Infant wide-field fundus photograph.
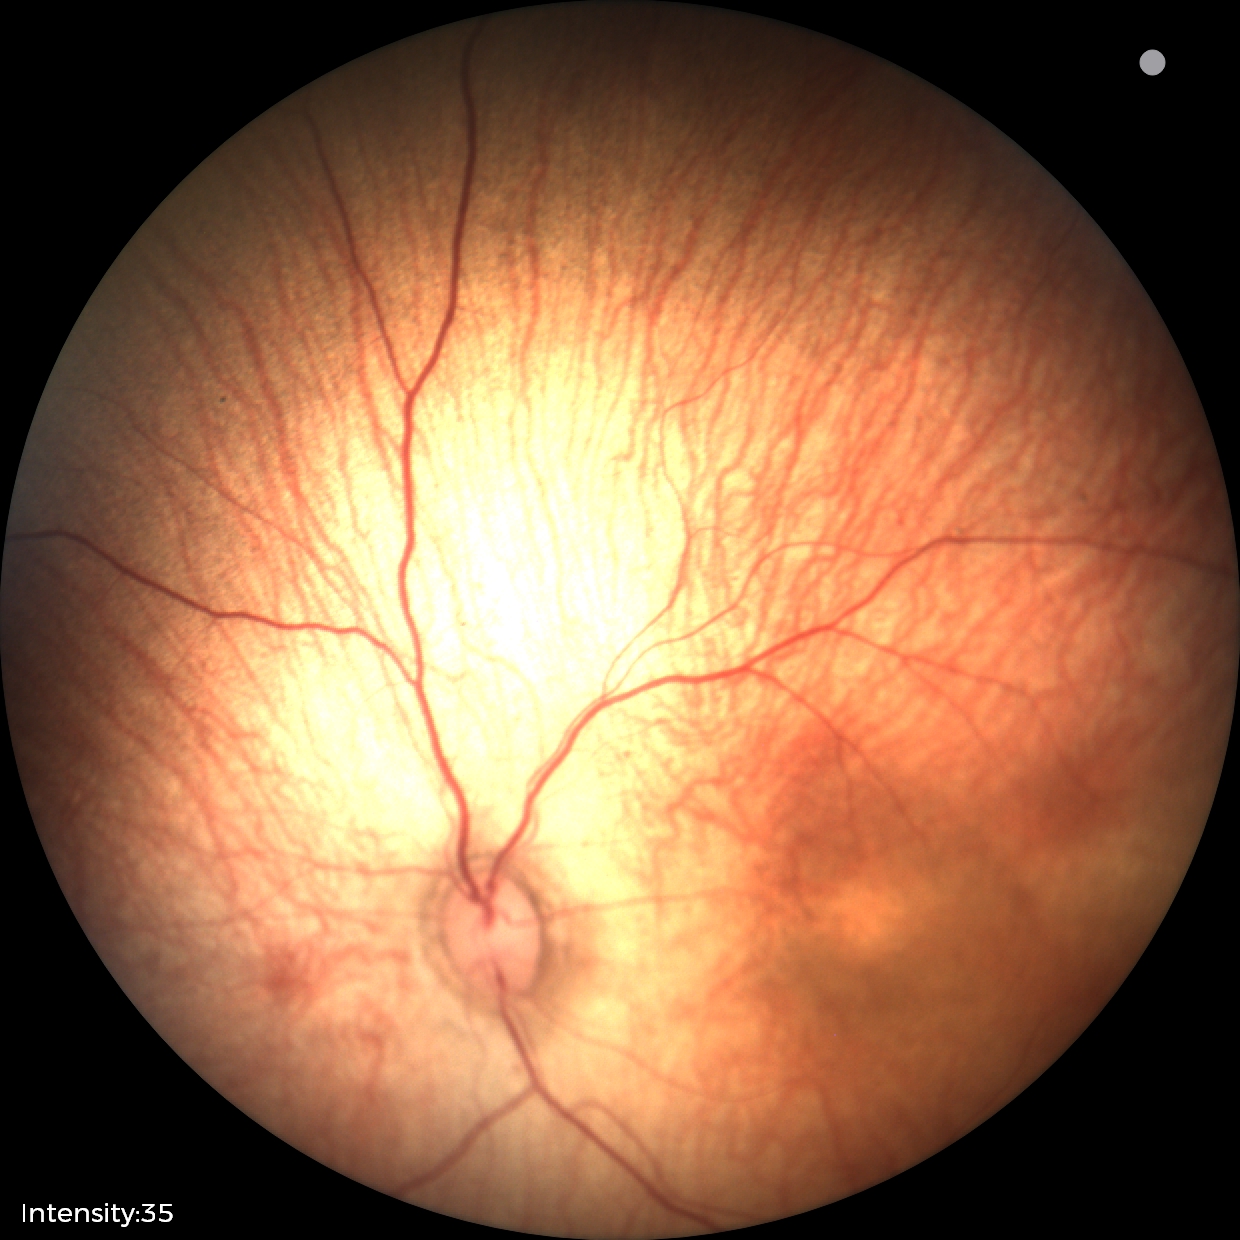 Screening series with status post retinopathy of prematurity (ROP).